Non-mydriatic fundus camera
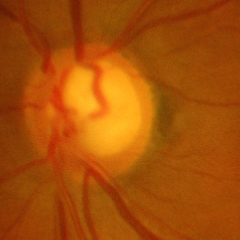 There is evidence of severe glaucomatous damage.